Image size 2352x1568. 45° FOV. Retinal fundus photograph.
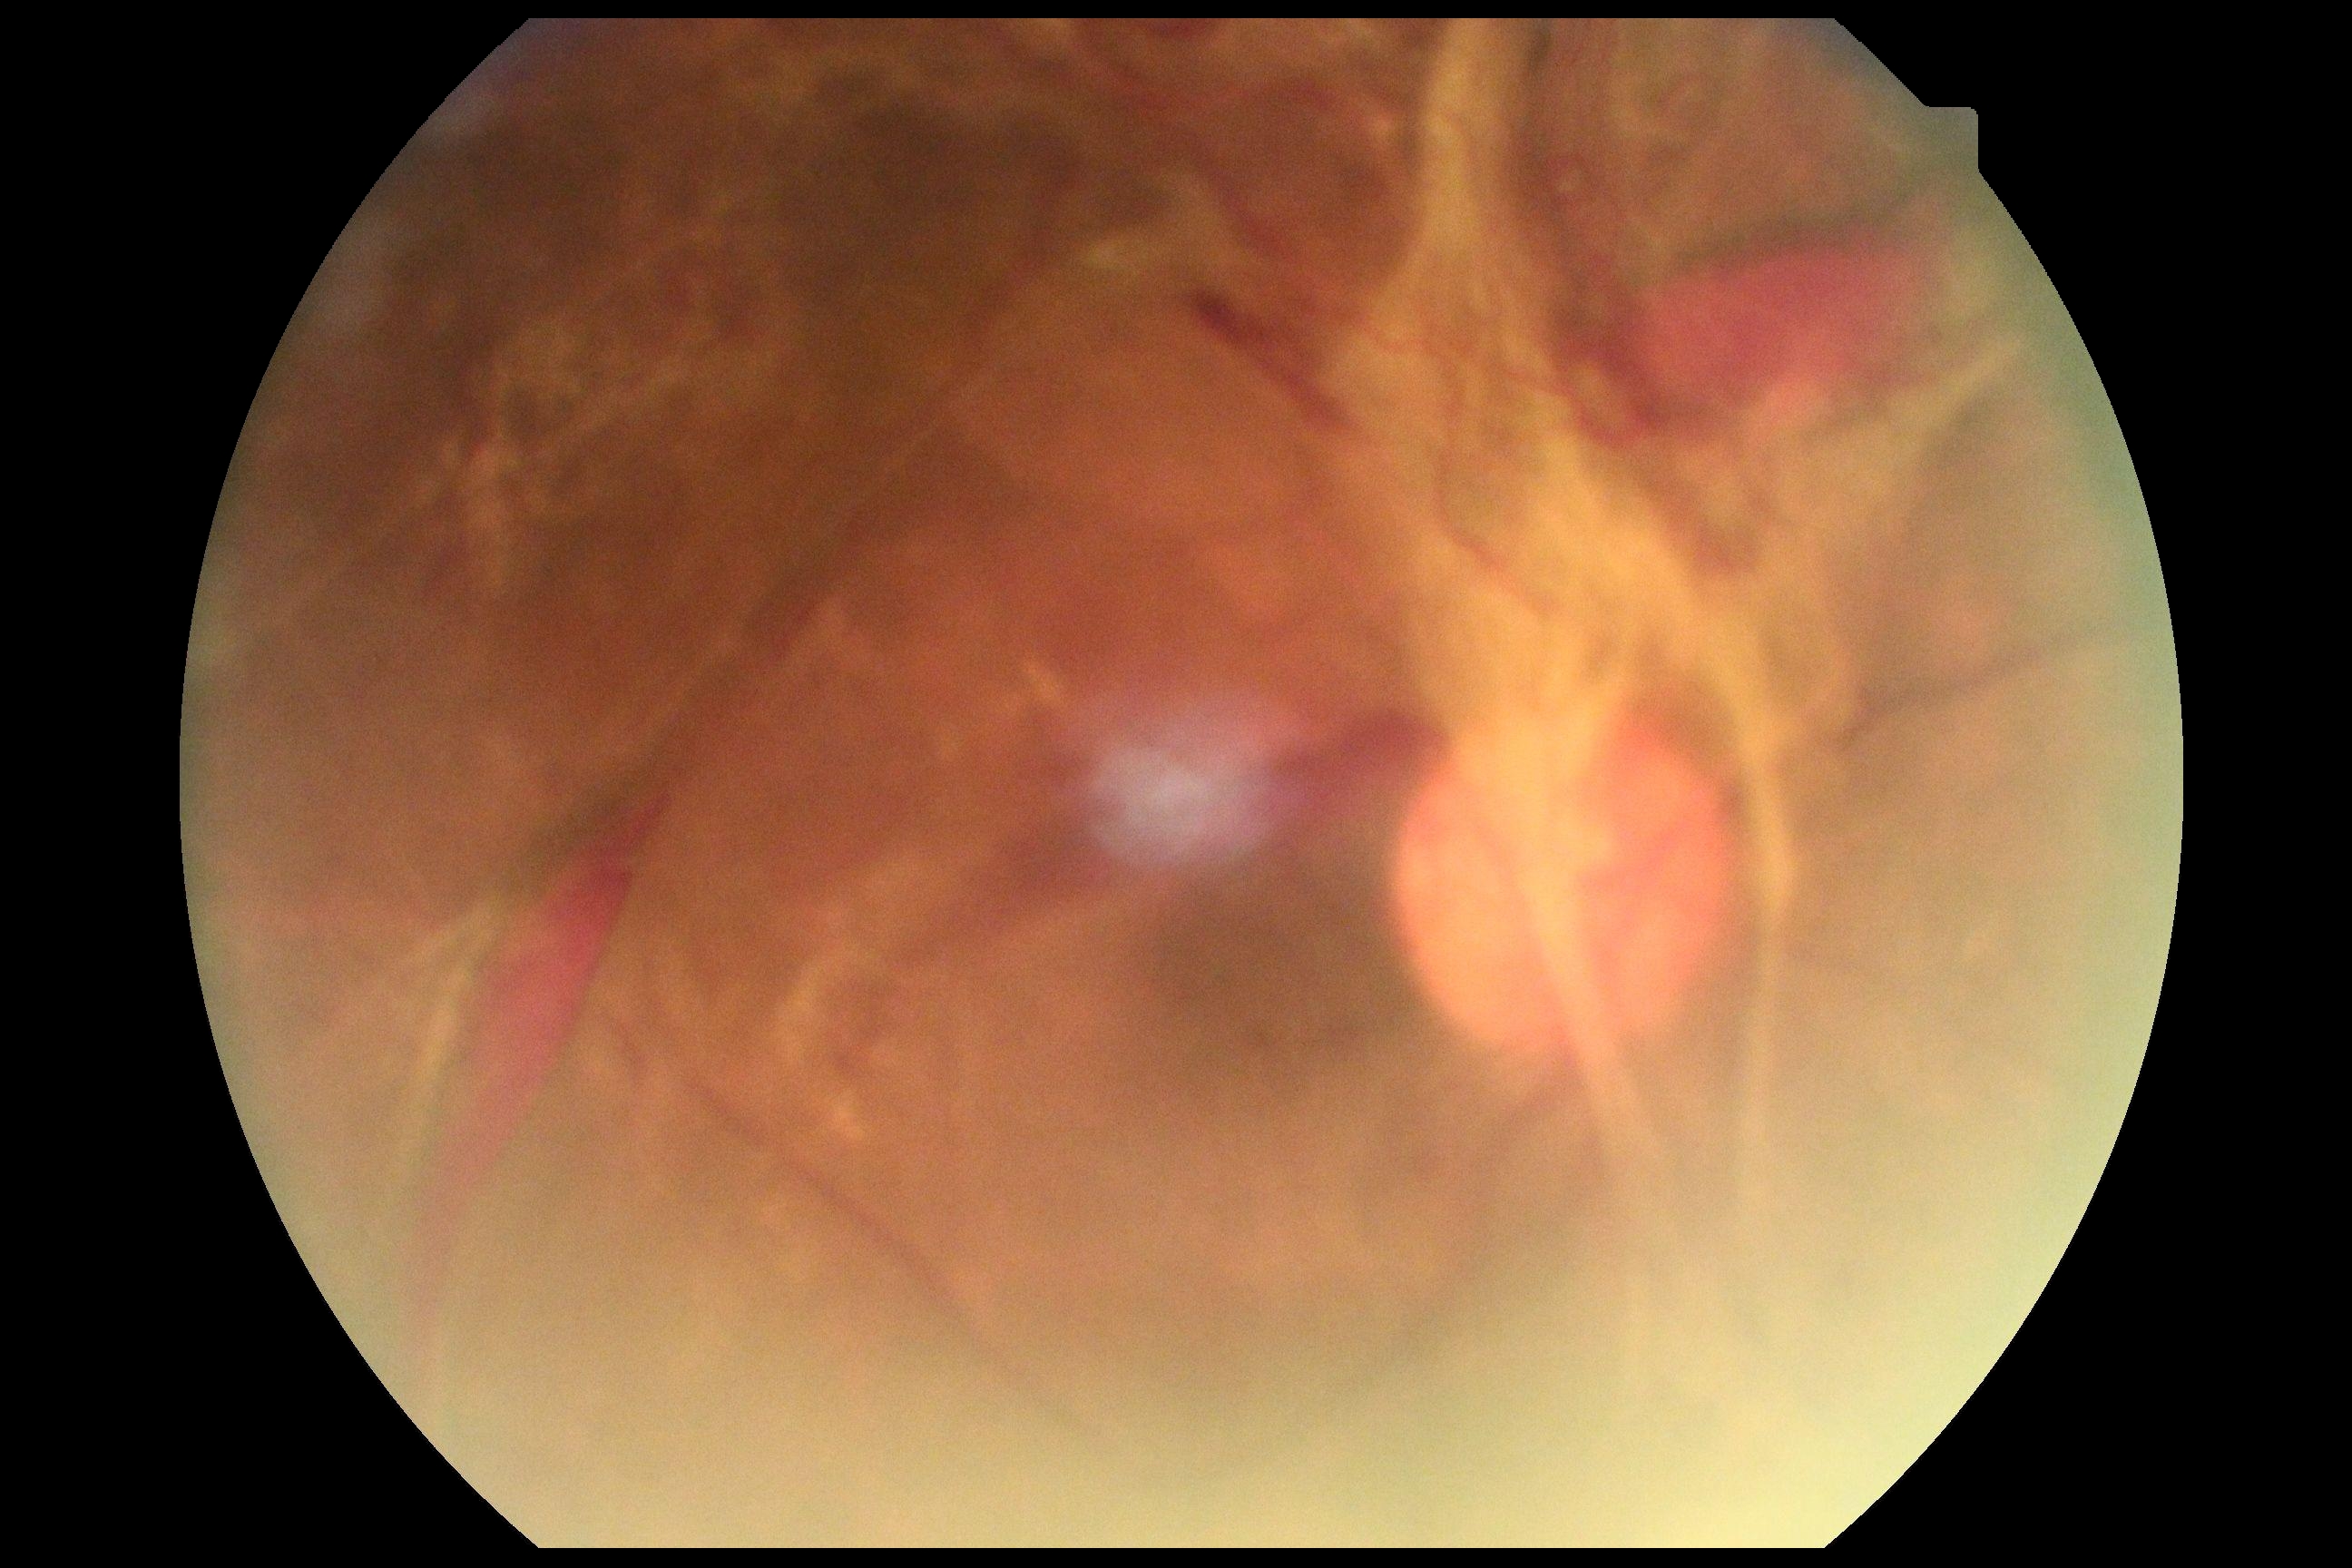 Diabetic retinopathy (DR): proliferative diabetic retinopathy (grade 4).